Wide-field fundus photograph of an infant — 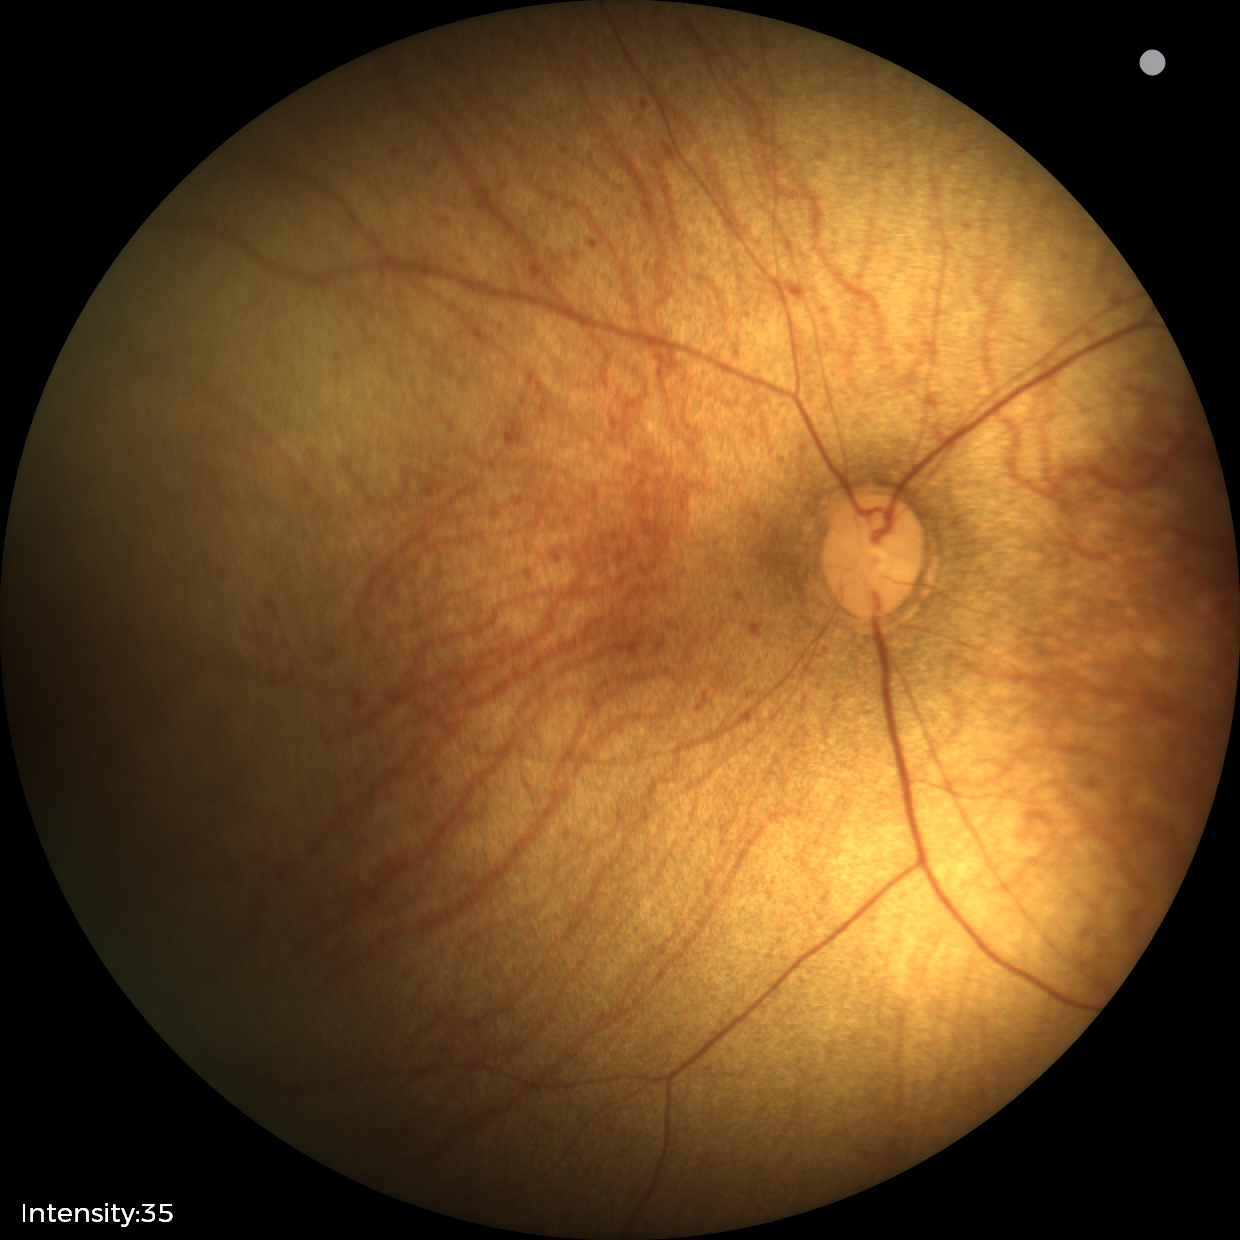
Examination with physiological retinal findings.